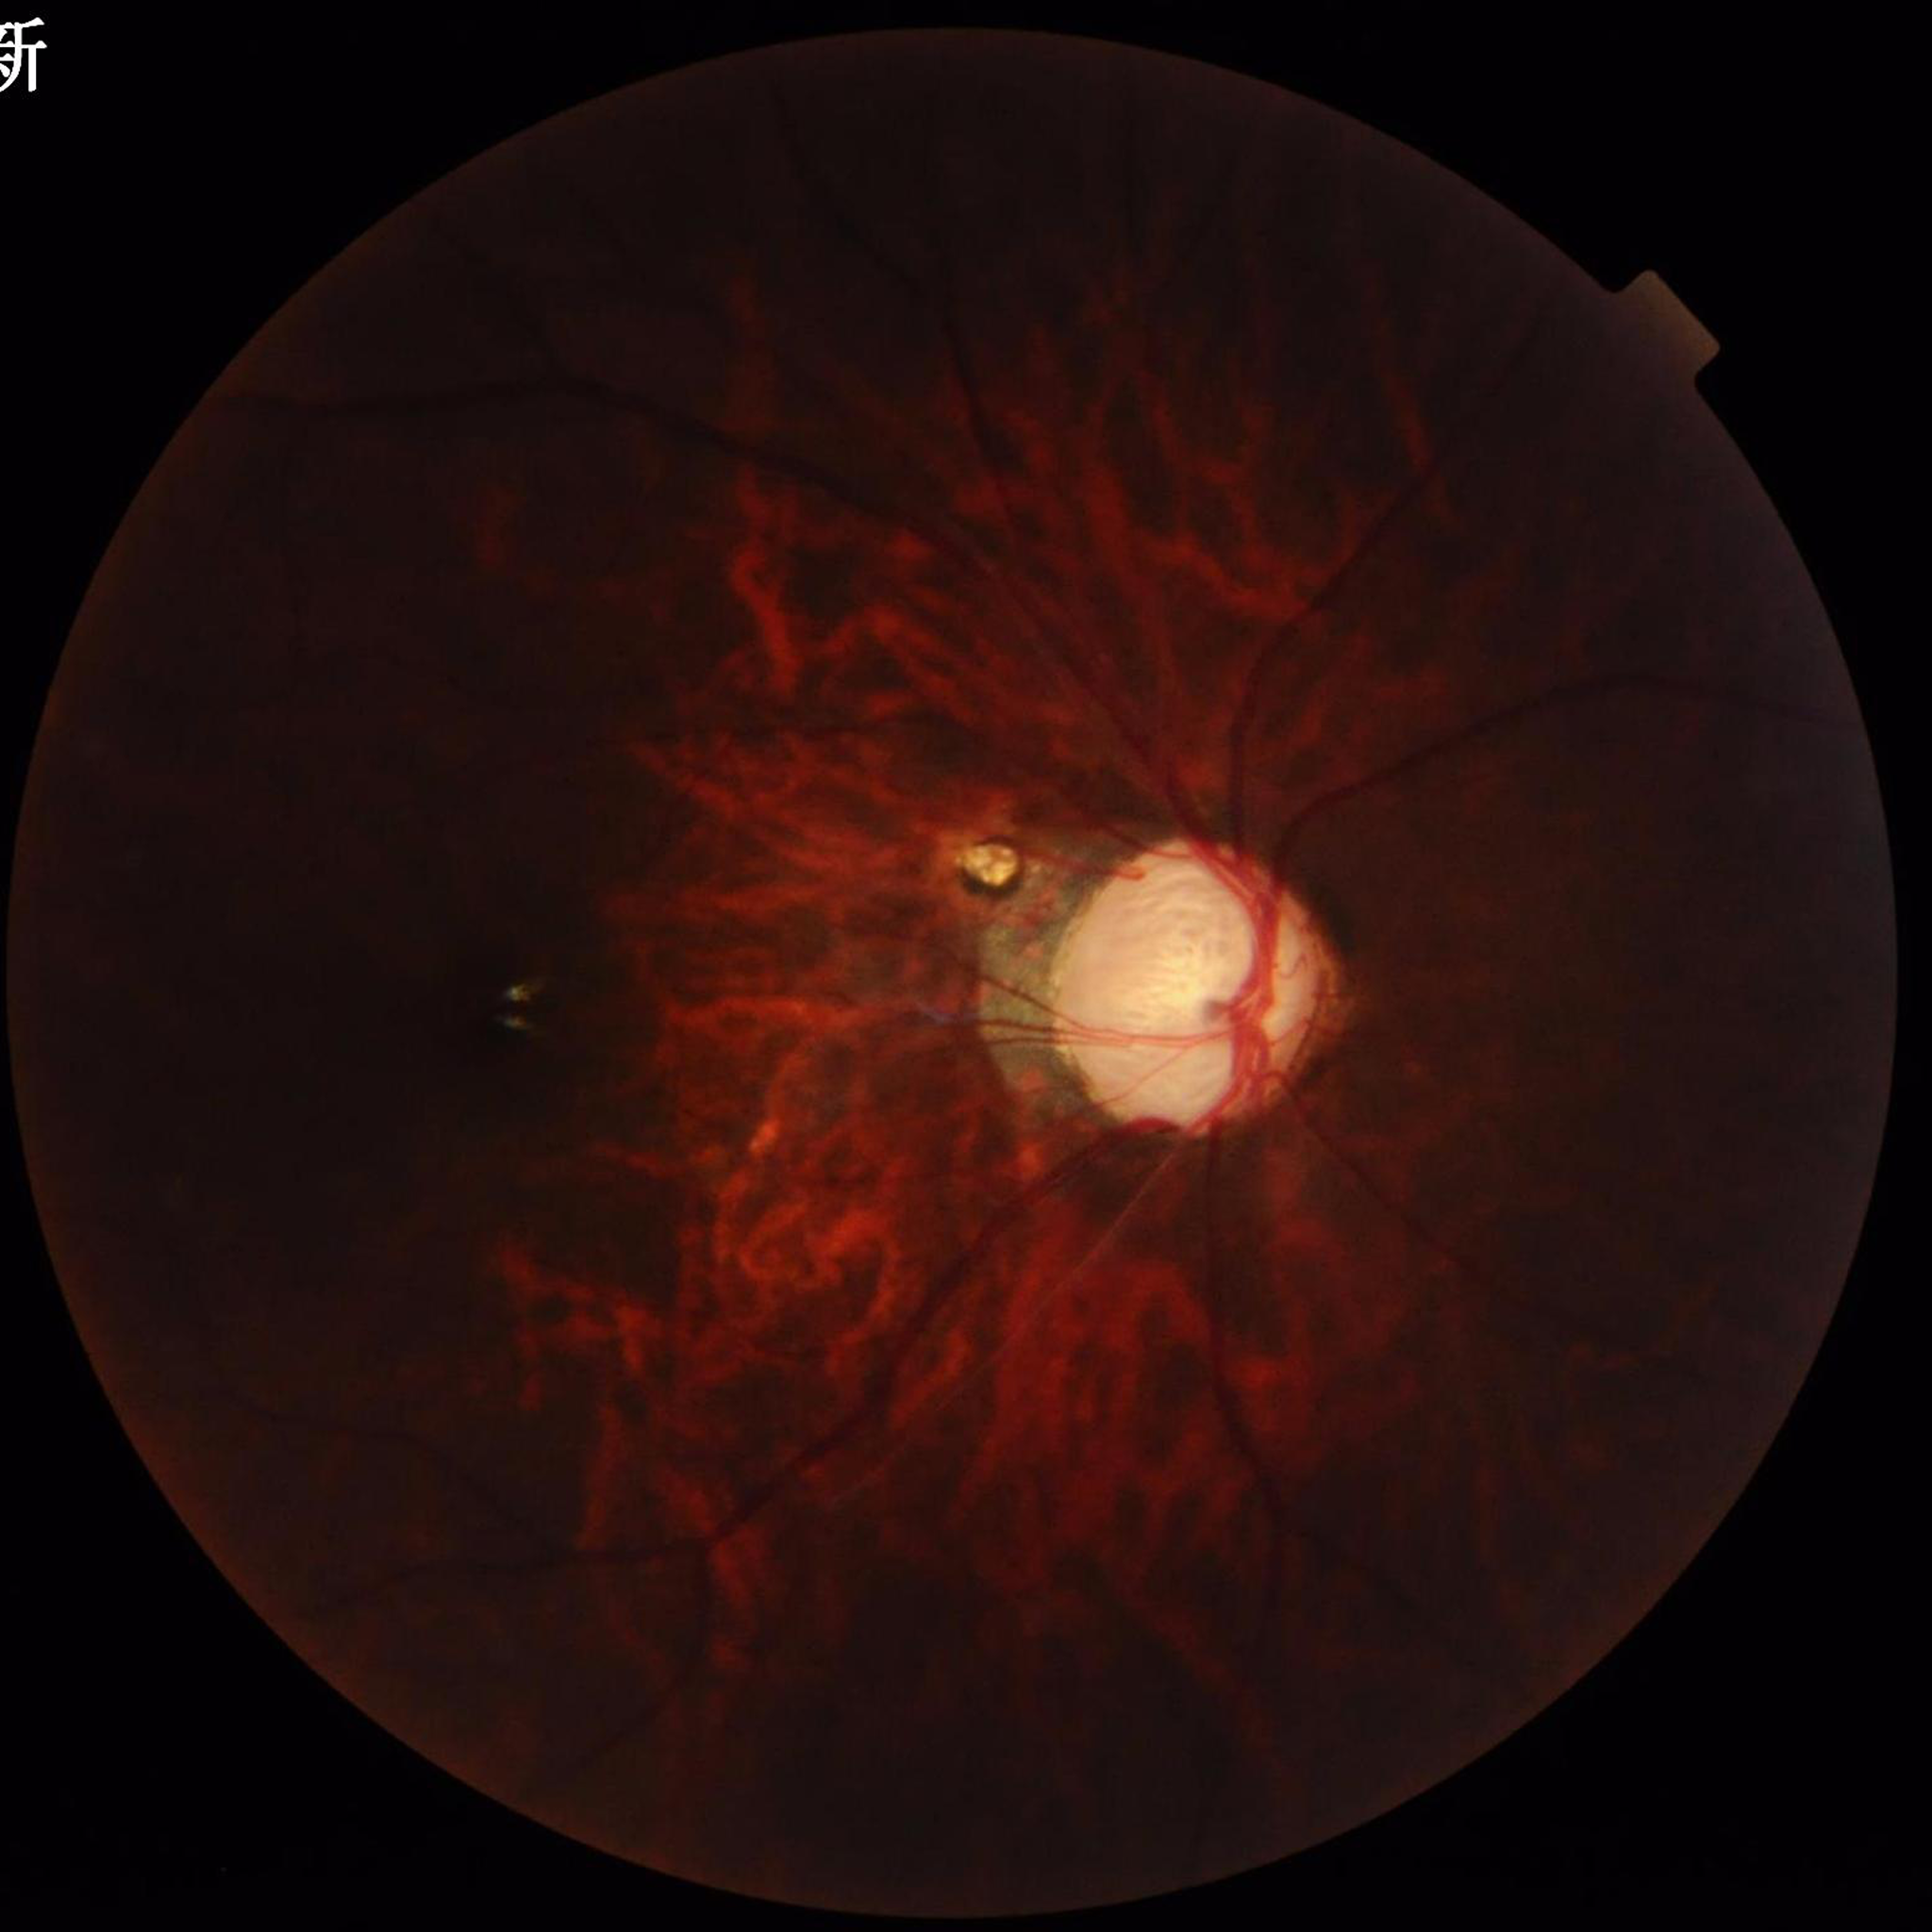
Eye affected by glaucoma. Quality assessment: issues noted — illumination/color distortion, blur.